45° field of view:
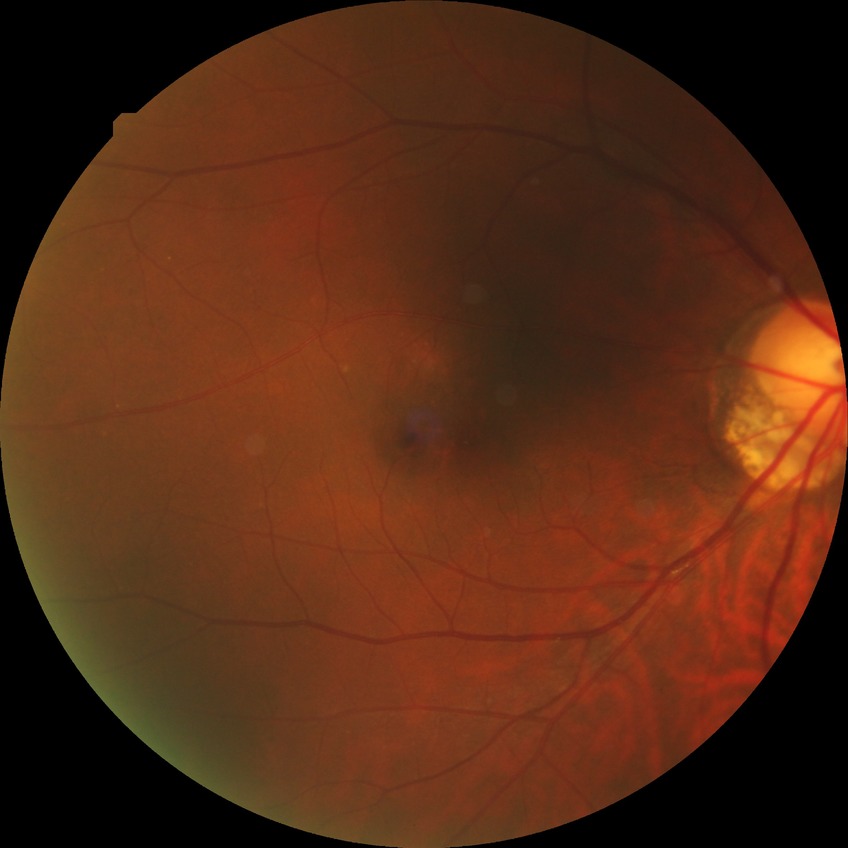
Assessment:
- diabetic retinopathy (DR): no diabetic retinopathy (NDR)